Modified Davis grading — 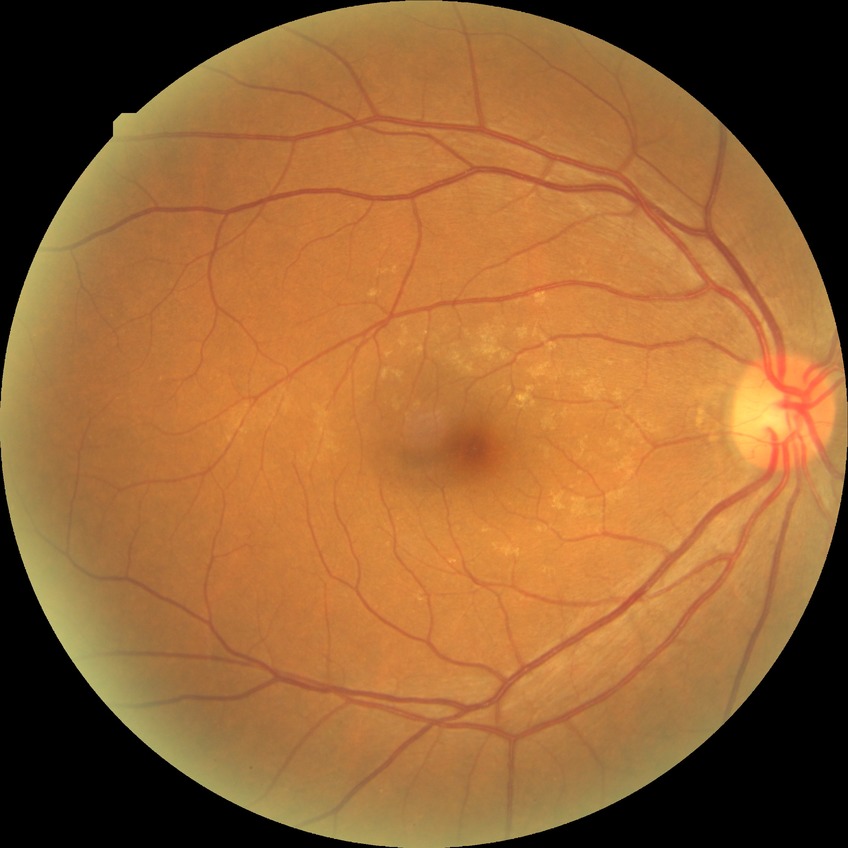 Diabetic retinopathy grade is no diabetic retinopathy.